Wide-field contact fundus photograph of an infant · 100° field of view (Phoenix ICON)
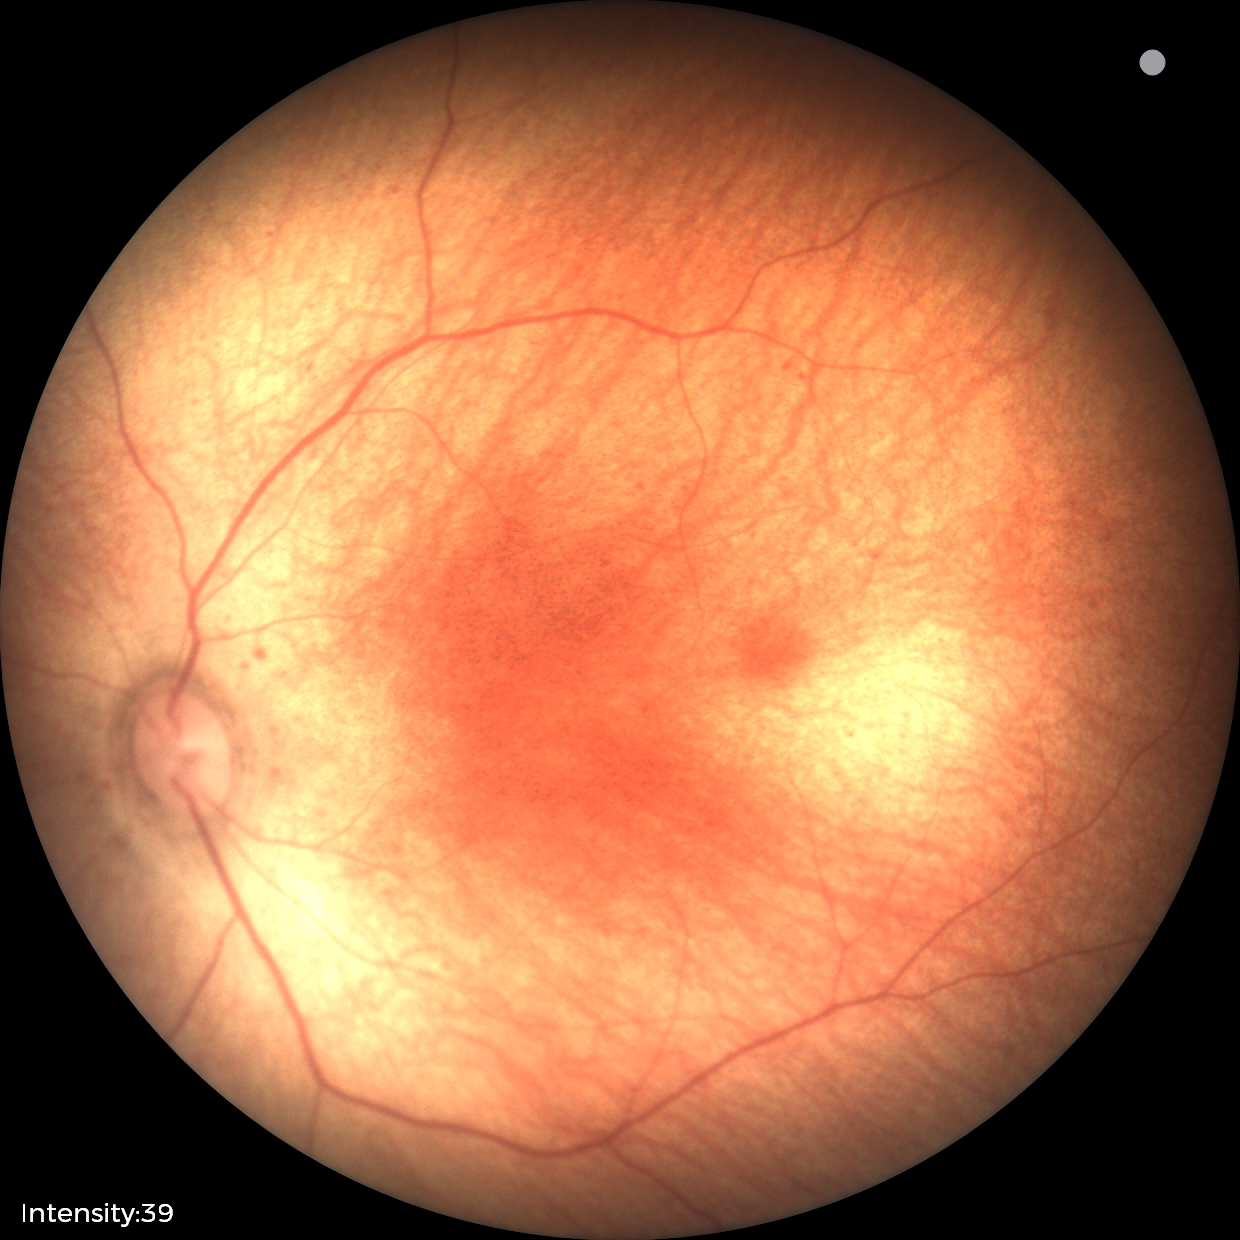

Normal screening examination.